240x240; non-mydriatic acquisition.
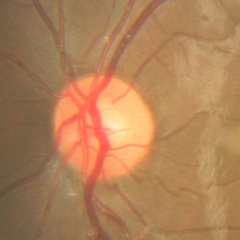 Fundus image with findings of no glaucomatous findings.